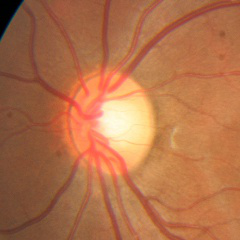
No glaucomatous optic neuropathy.